Captured after pupil dilation · 50-degree field of view
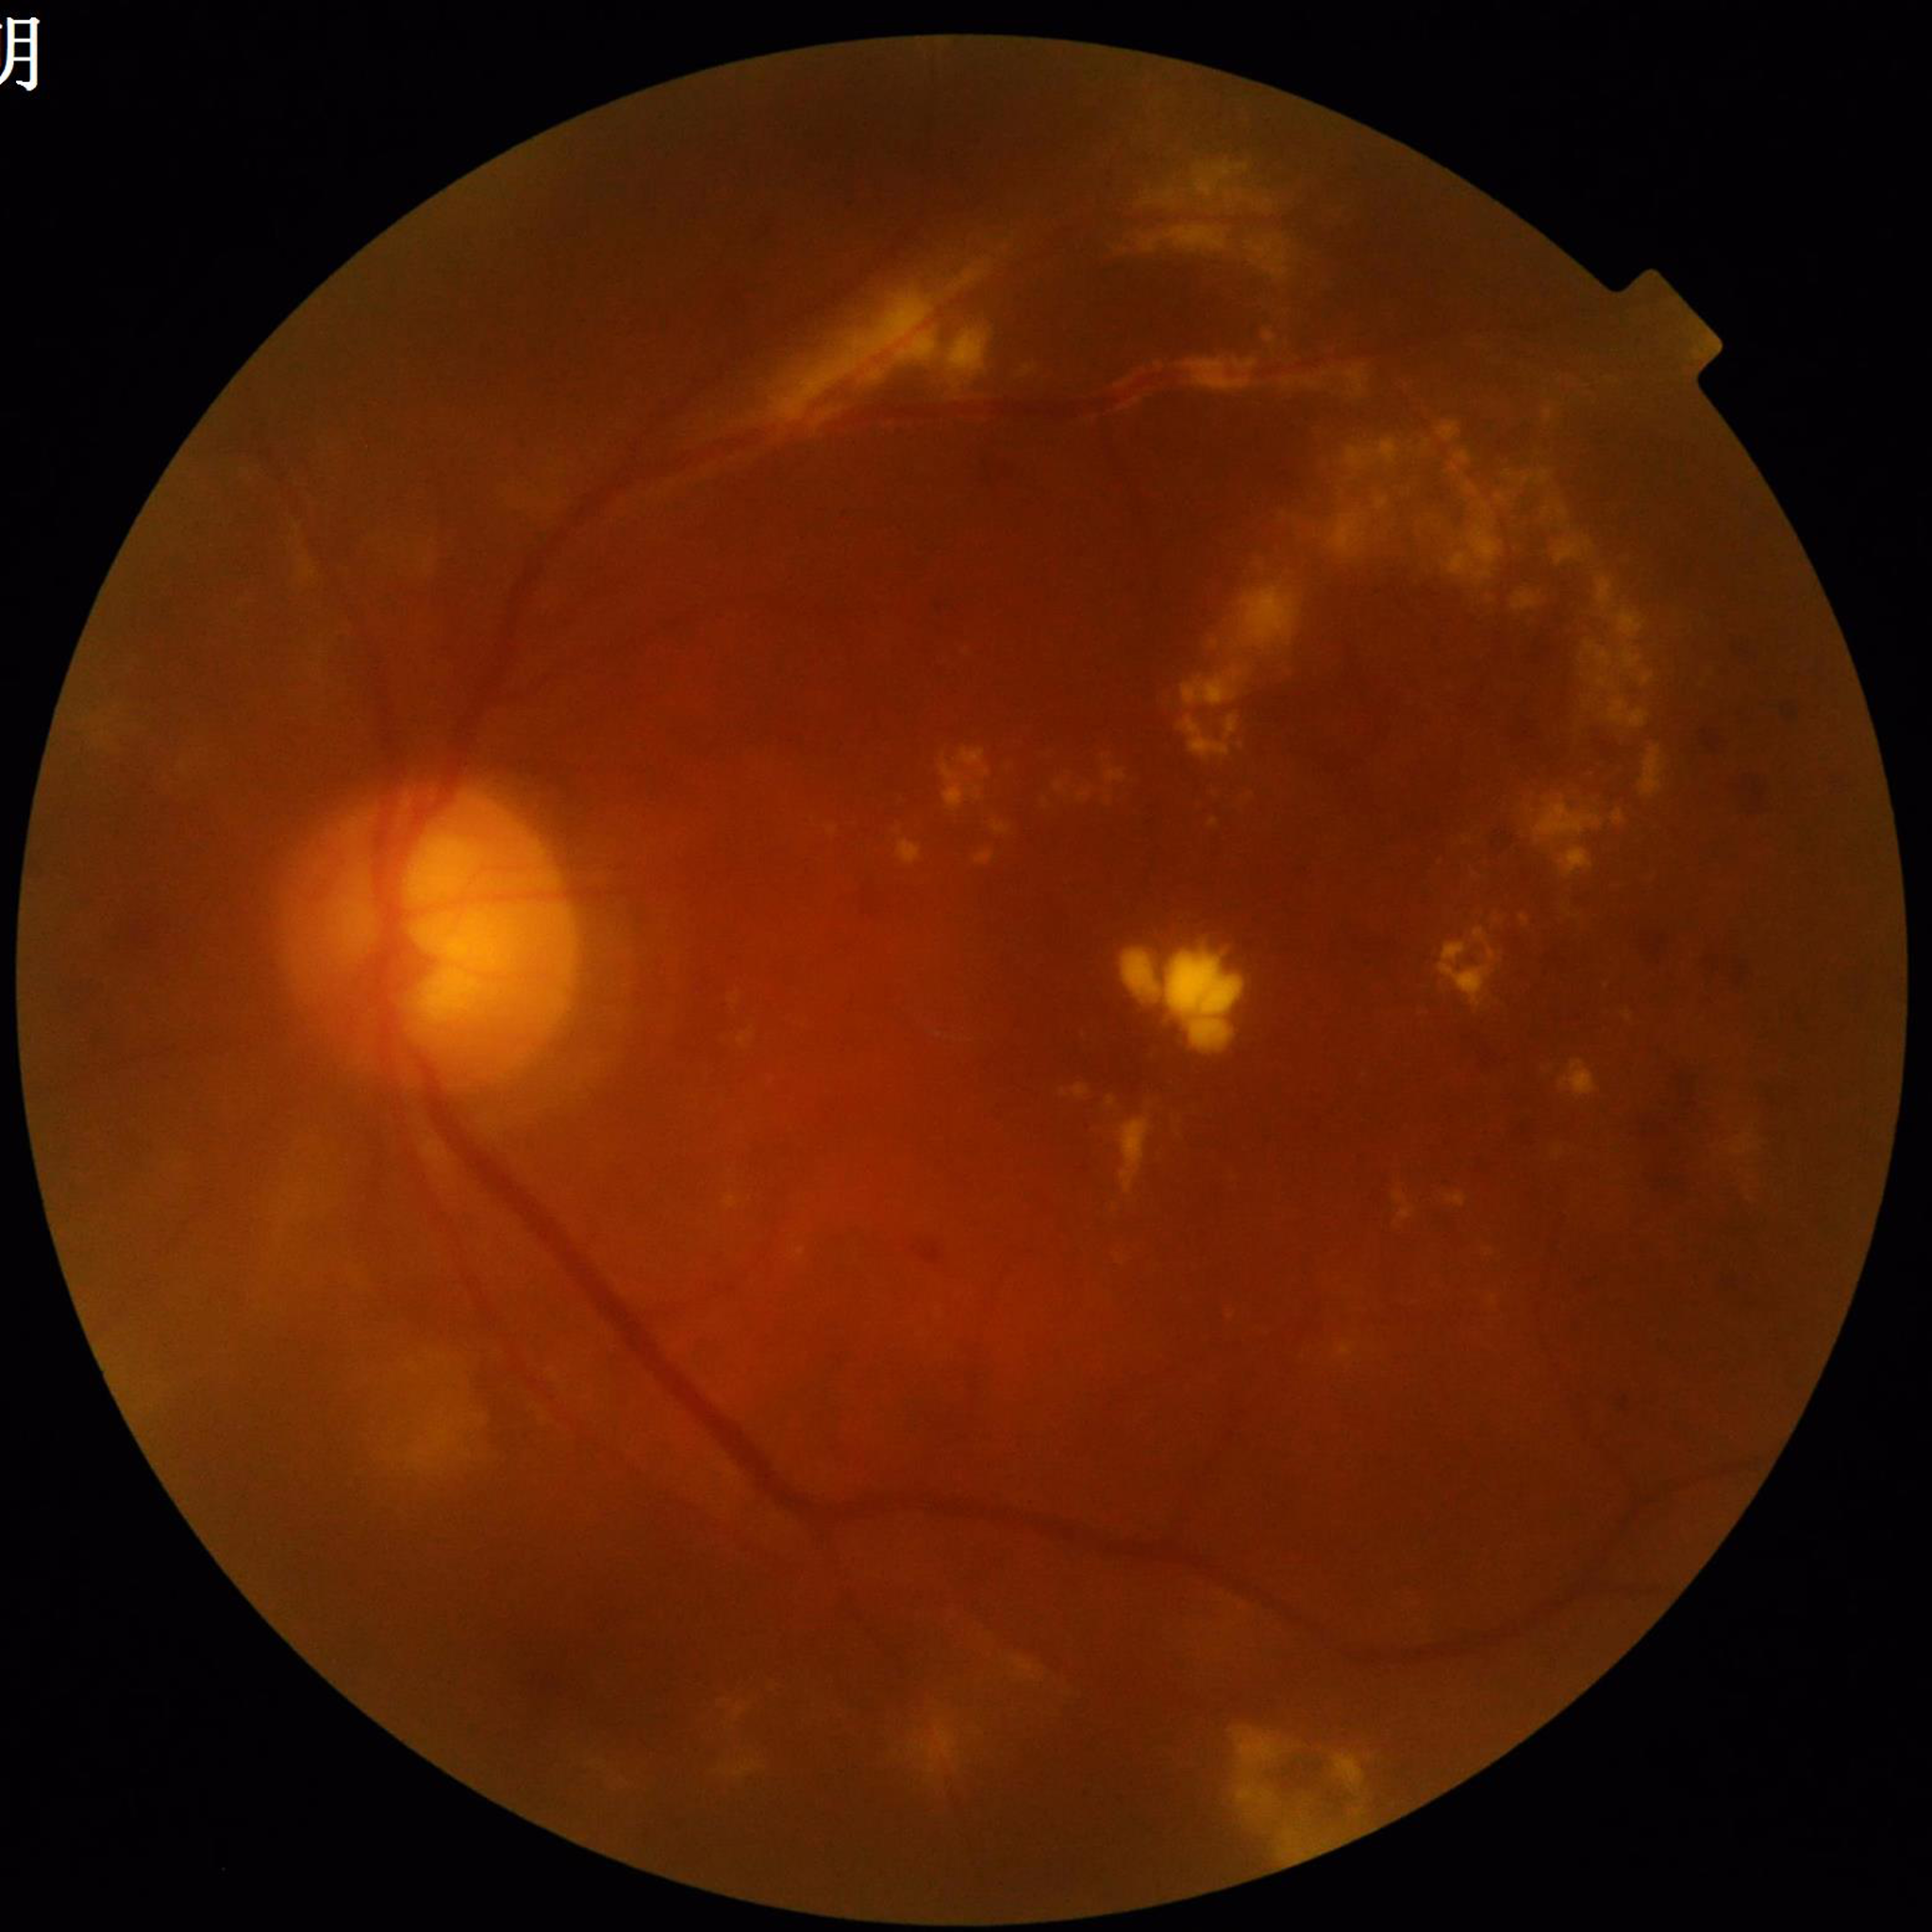

Quality: poor — blur. From a patient with DR.